Camera: Phoenix ICON (100° FOV) · 1240x1240px · pediatric retinal photograph (wide-field): 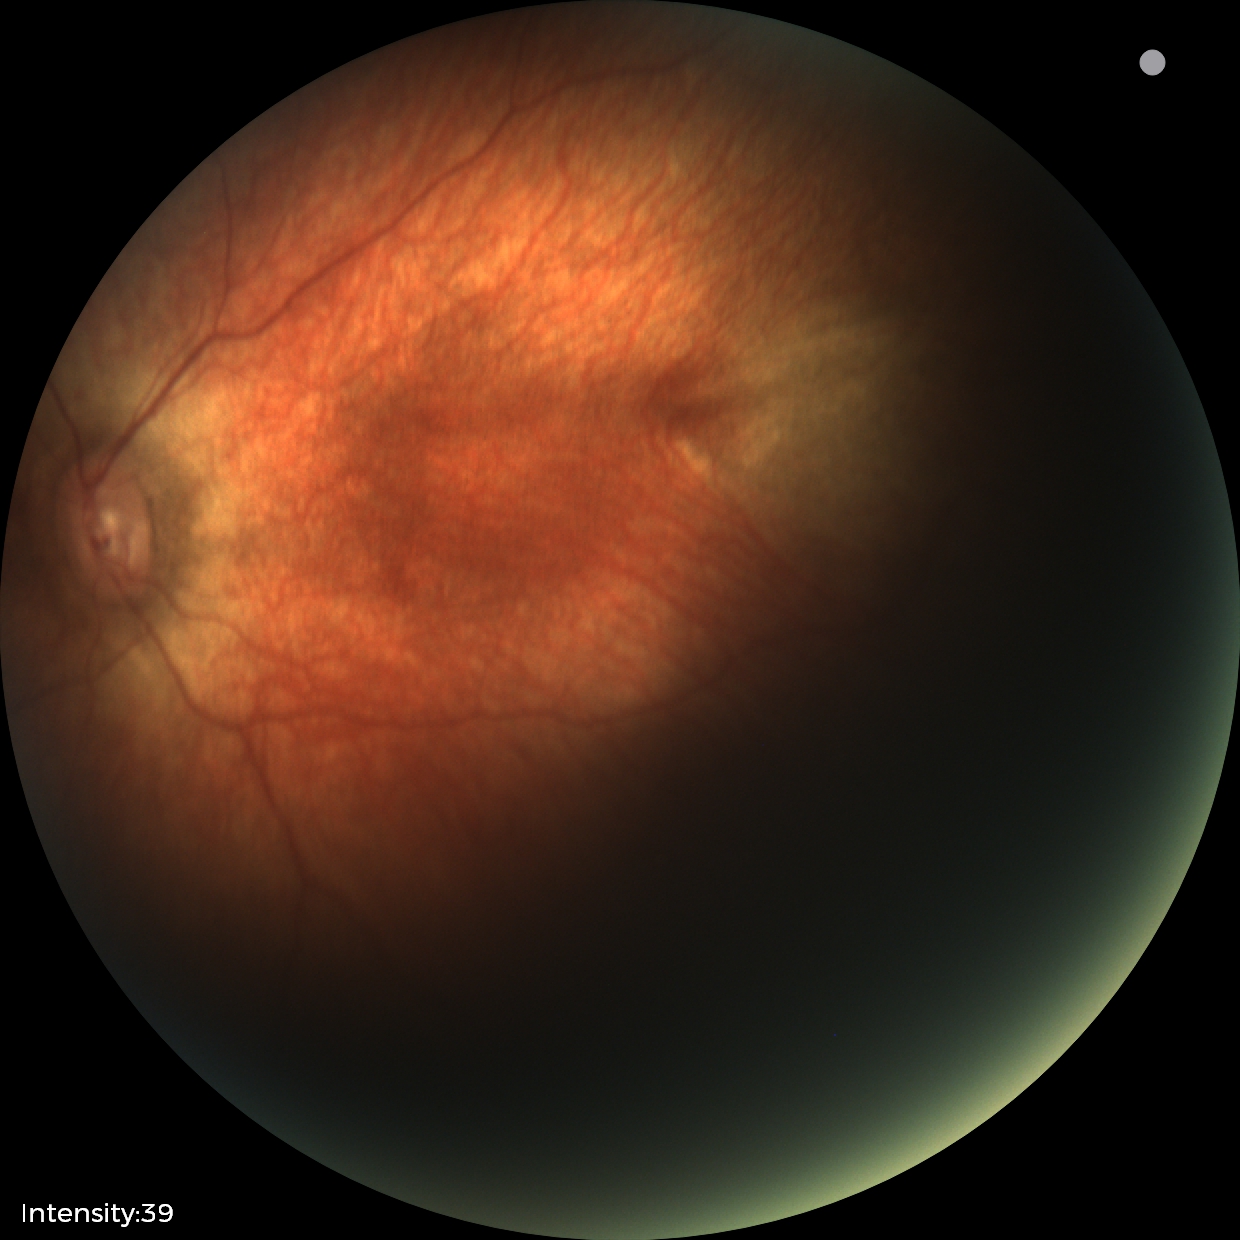
Examination with physiological retinal findings.